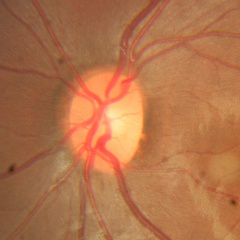 Optic nerve head appearance consistent with no glaucomatous findings.